848x848; FOV: 45 degrees; modified Davis grading; retinal fundus photograph; nonmydriatic fundus photograph — 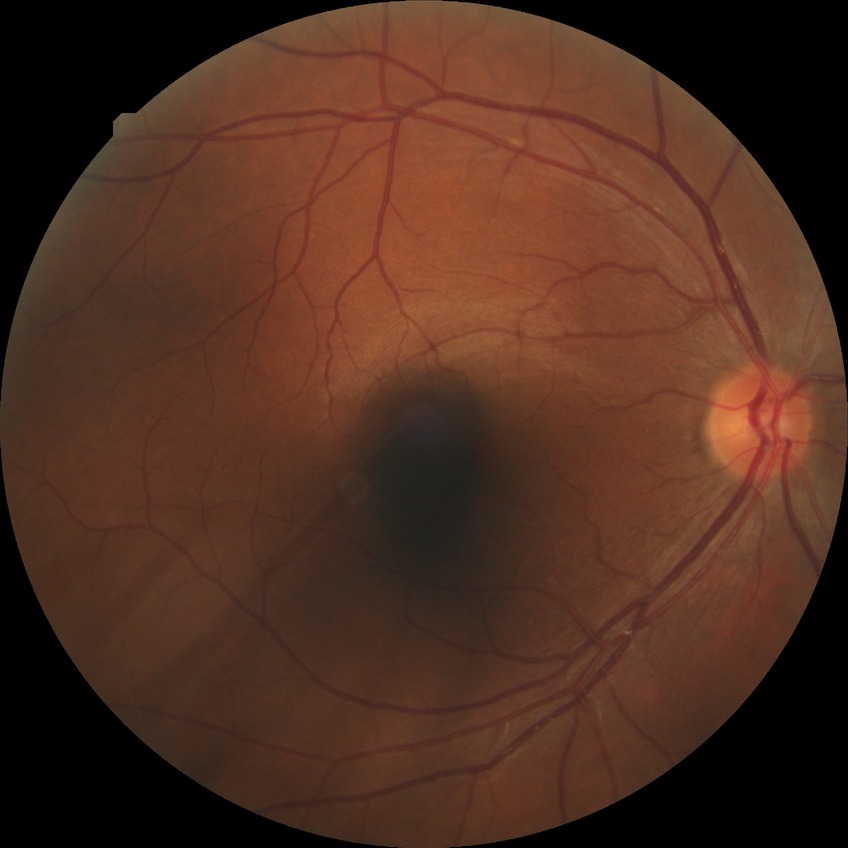

modified Davis grade: NDR | DR impression: no DR findings.